FOV: 45 degrees: 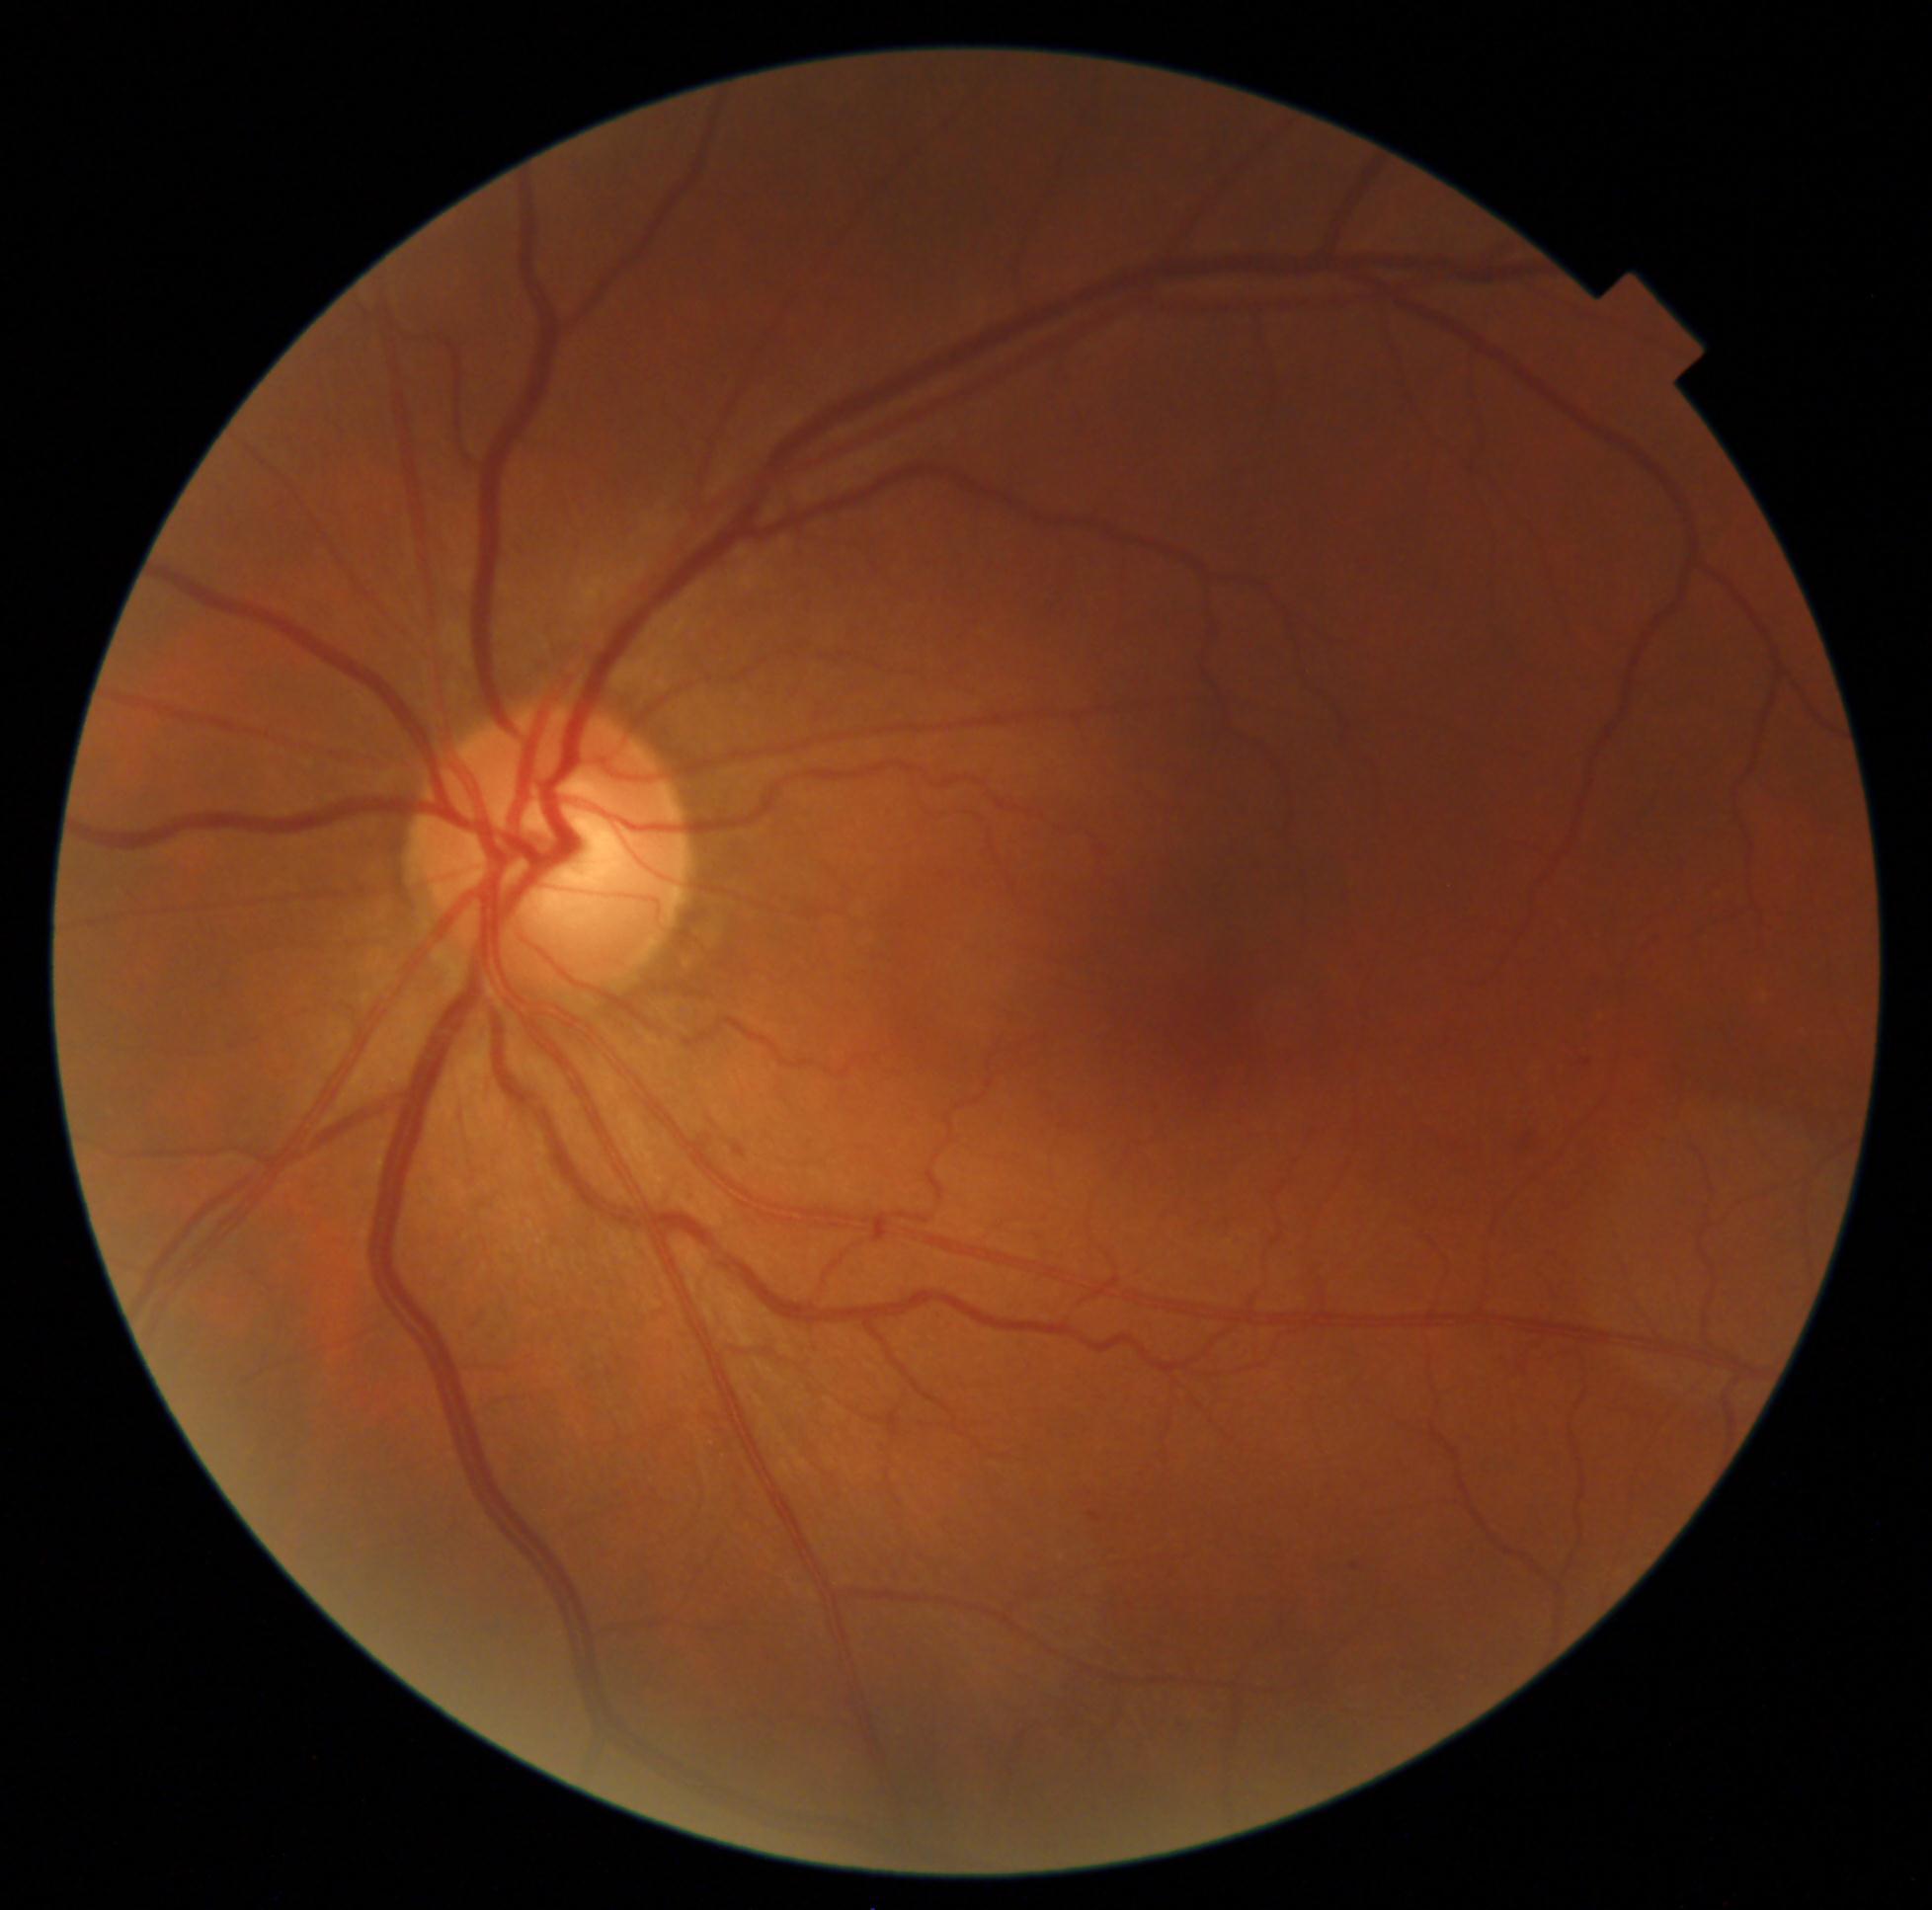
Diabetic retinopathy severity: grade 2 (moderate NPDR).